Davis DR grading. Color fundus image — 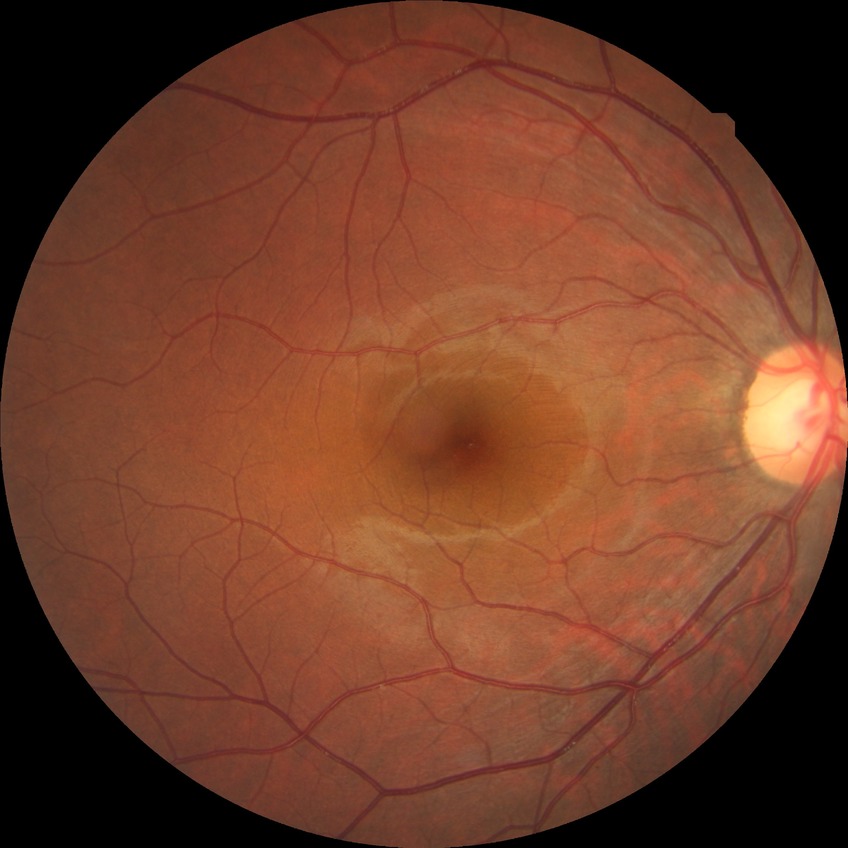 Diabetic retinopathy (DR): NDR (no diabetic retinopathy).